Non-mydriatic fundus camera:
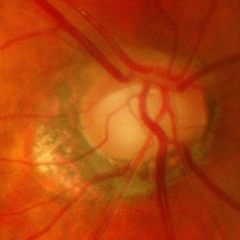
Showing advanced glaucomatous optic neuropathy. Defined as near-total cupping of the optic nerve head, with or without severe visual field loss within the central 10 degrees of fixation.